Acquired with a NIDEK AFC-230, FOV: 45 degrees, nonmydriatic: 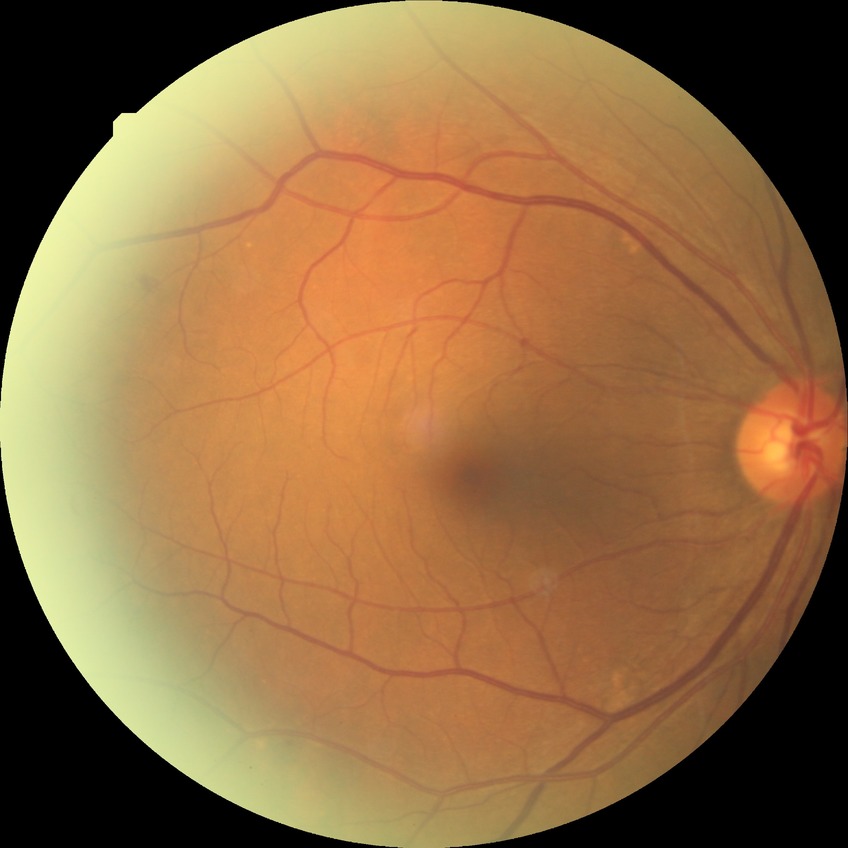

Retinopathy grade: no diabetic retinopathy.